45° FOV. 2212 x 1659 pixels. Color fundus photograph: 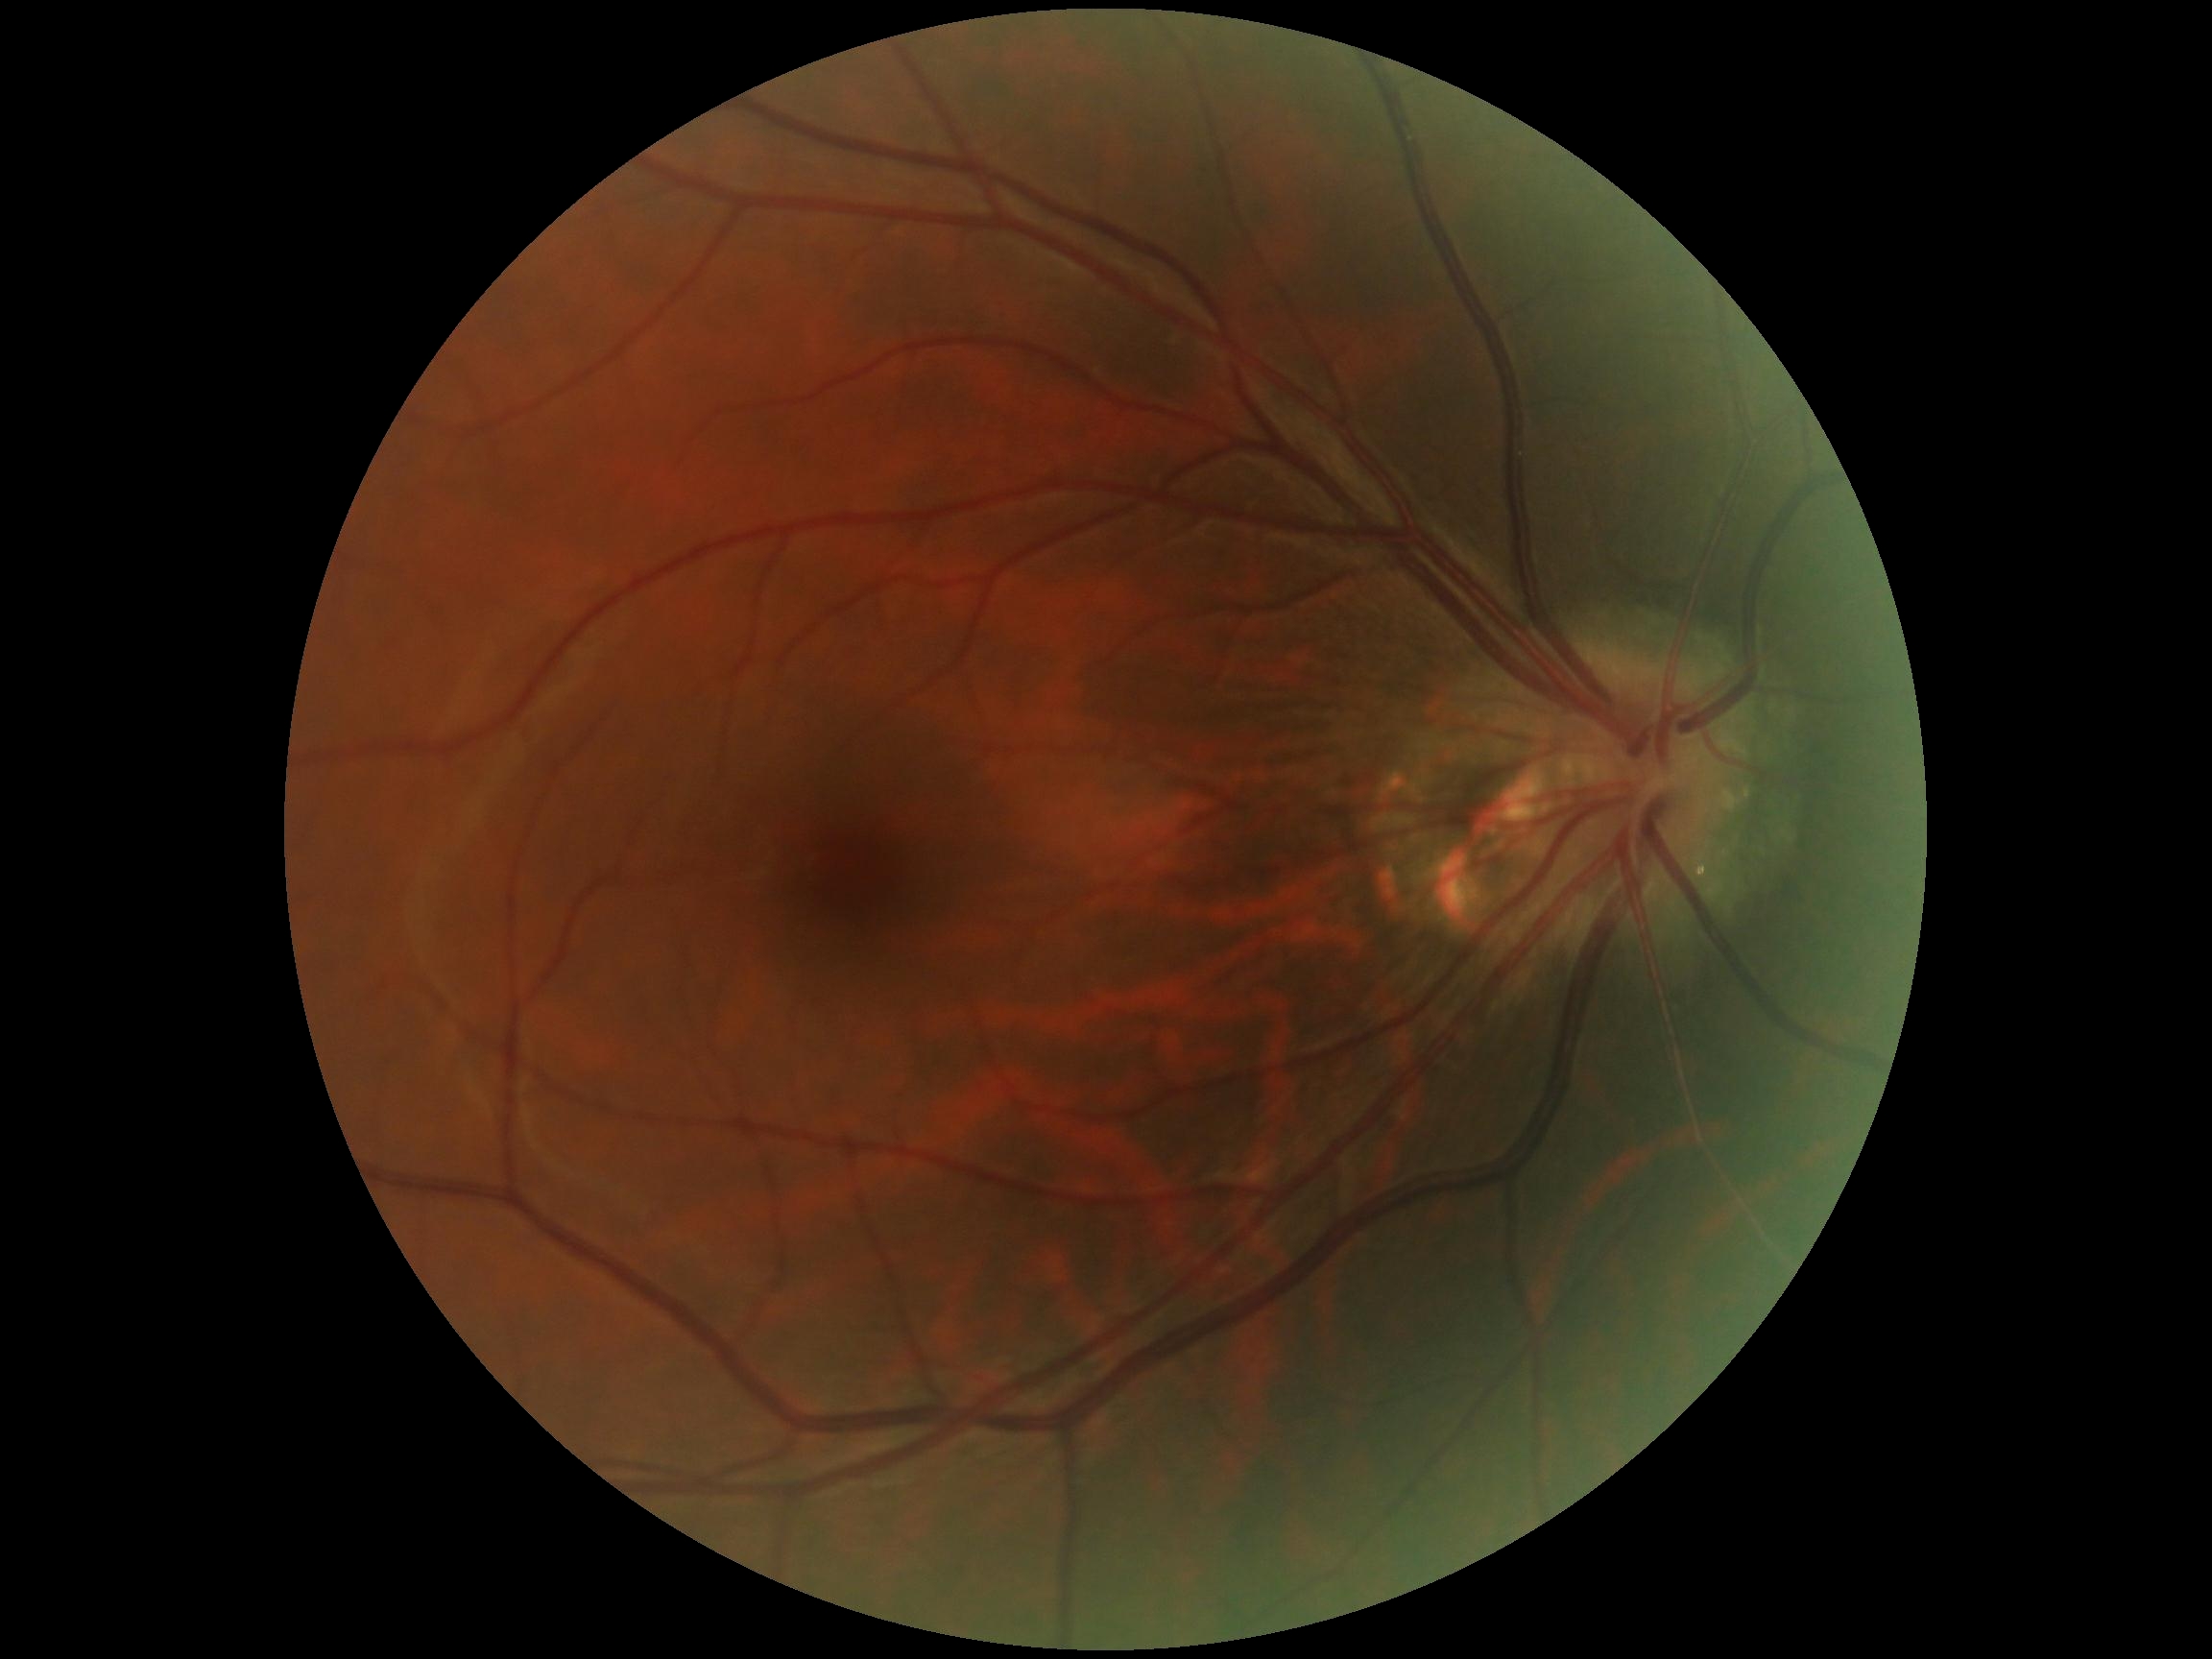 Findings:
- diabetic retinopathy grade — 0/4